Graded on the modified Davis scale:
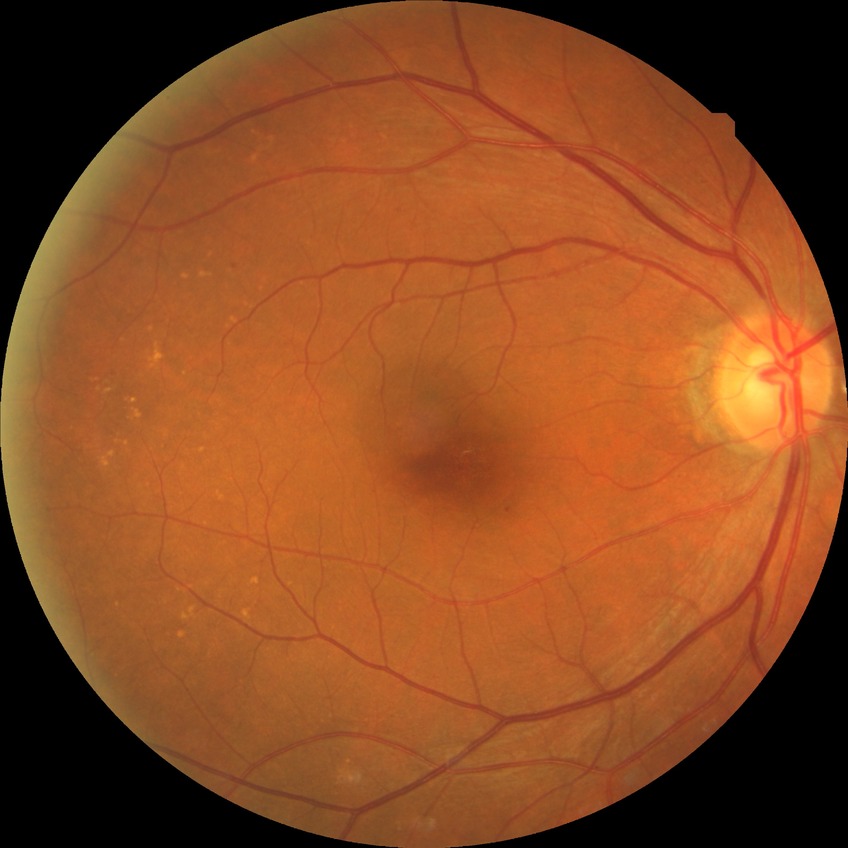

diabetic retinopathy (DR)=NDR (no diabetic retinopathy).